Retinal fundus photograph · 512x512px: 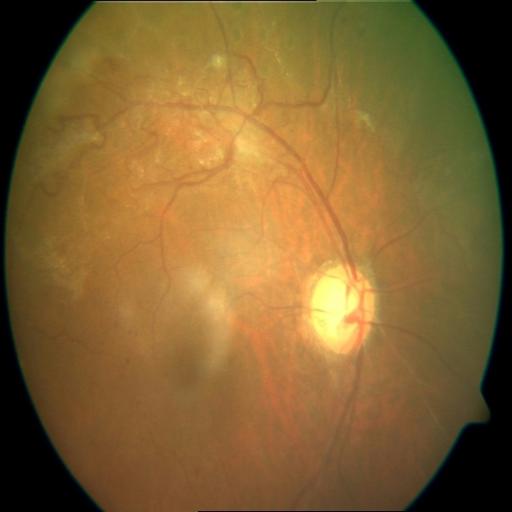
Findings consistent with collateral vessels.